Retinal fundus photograph — 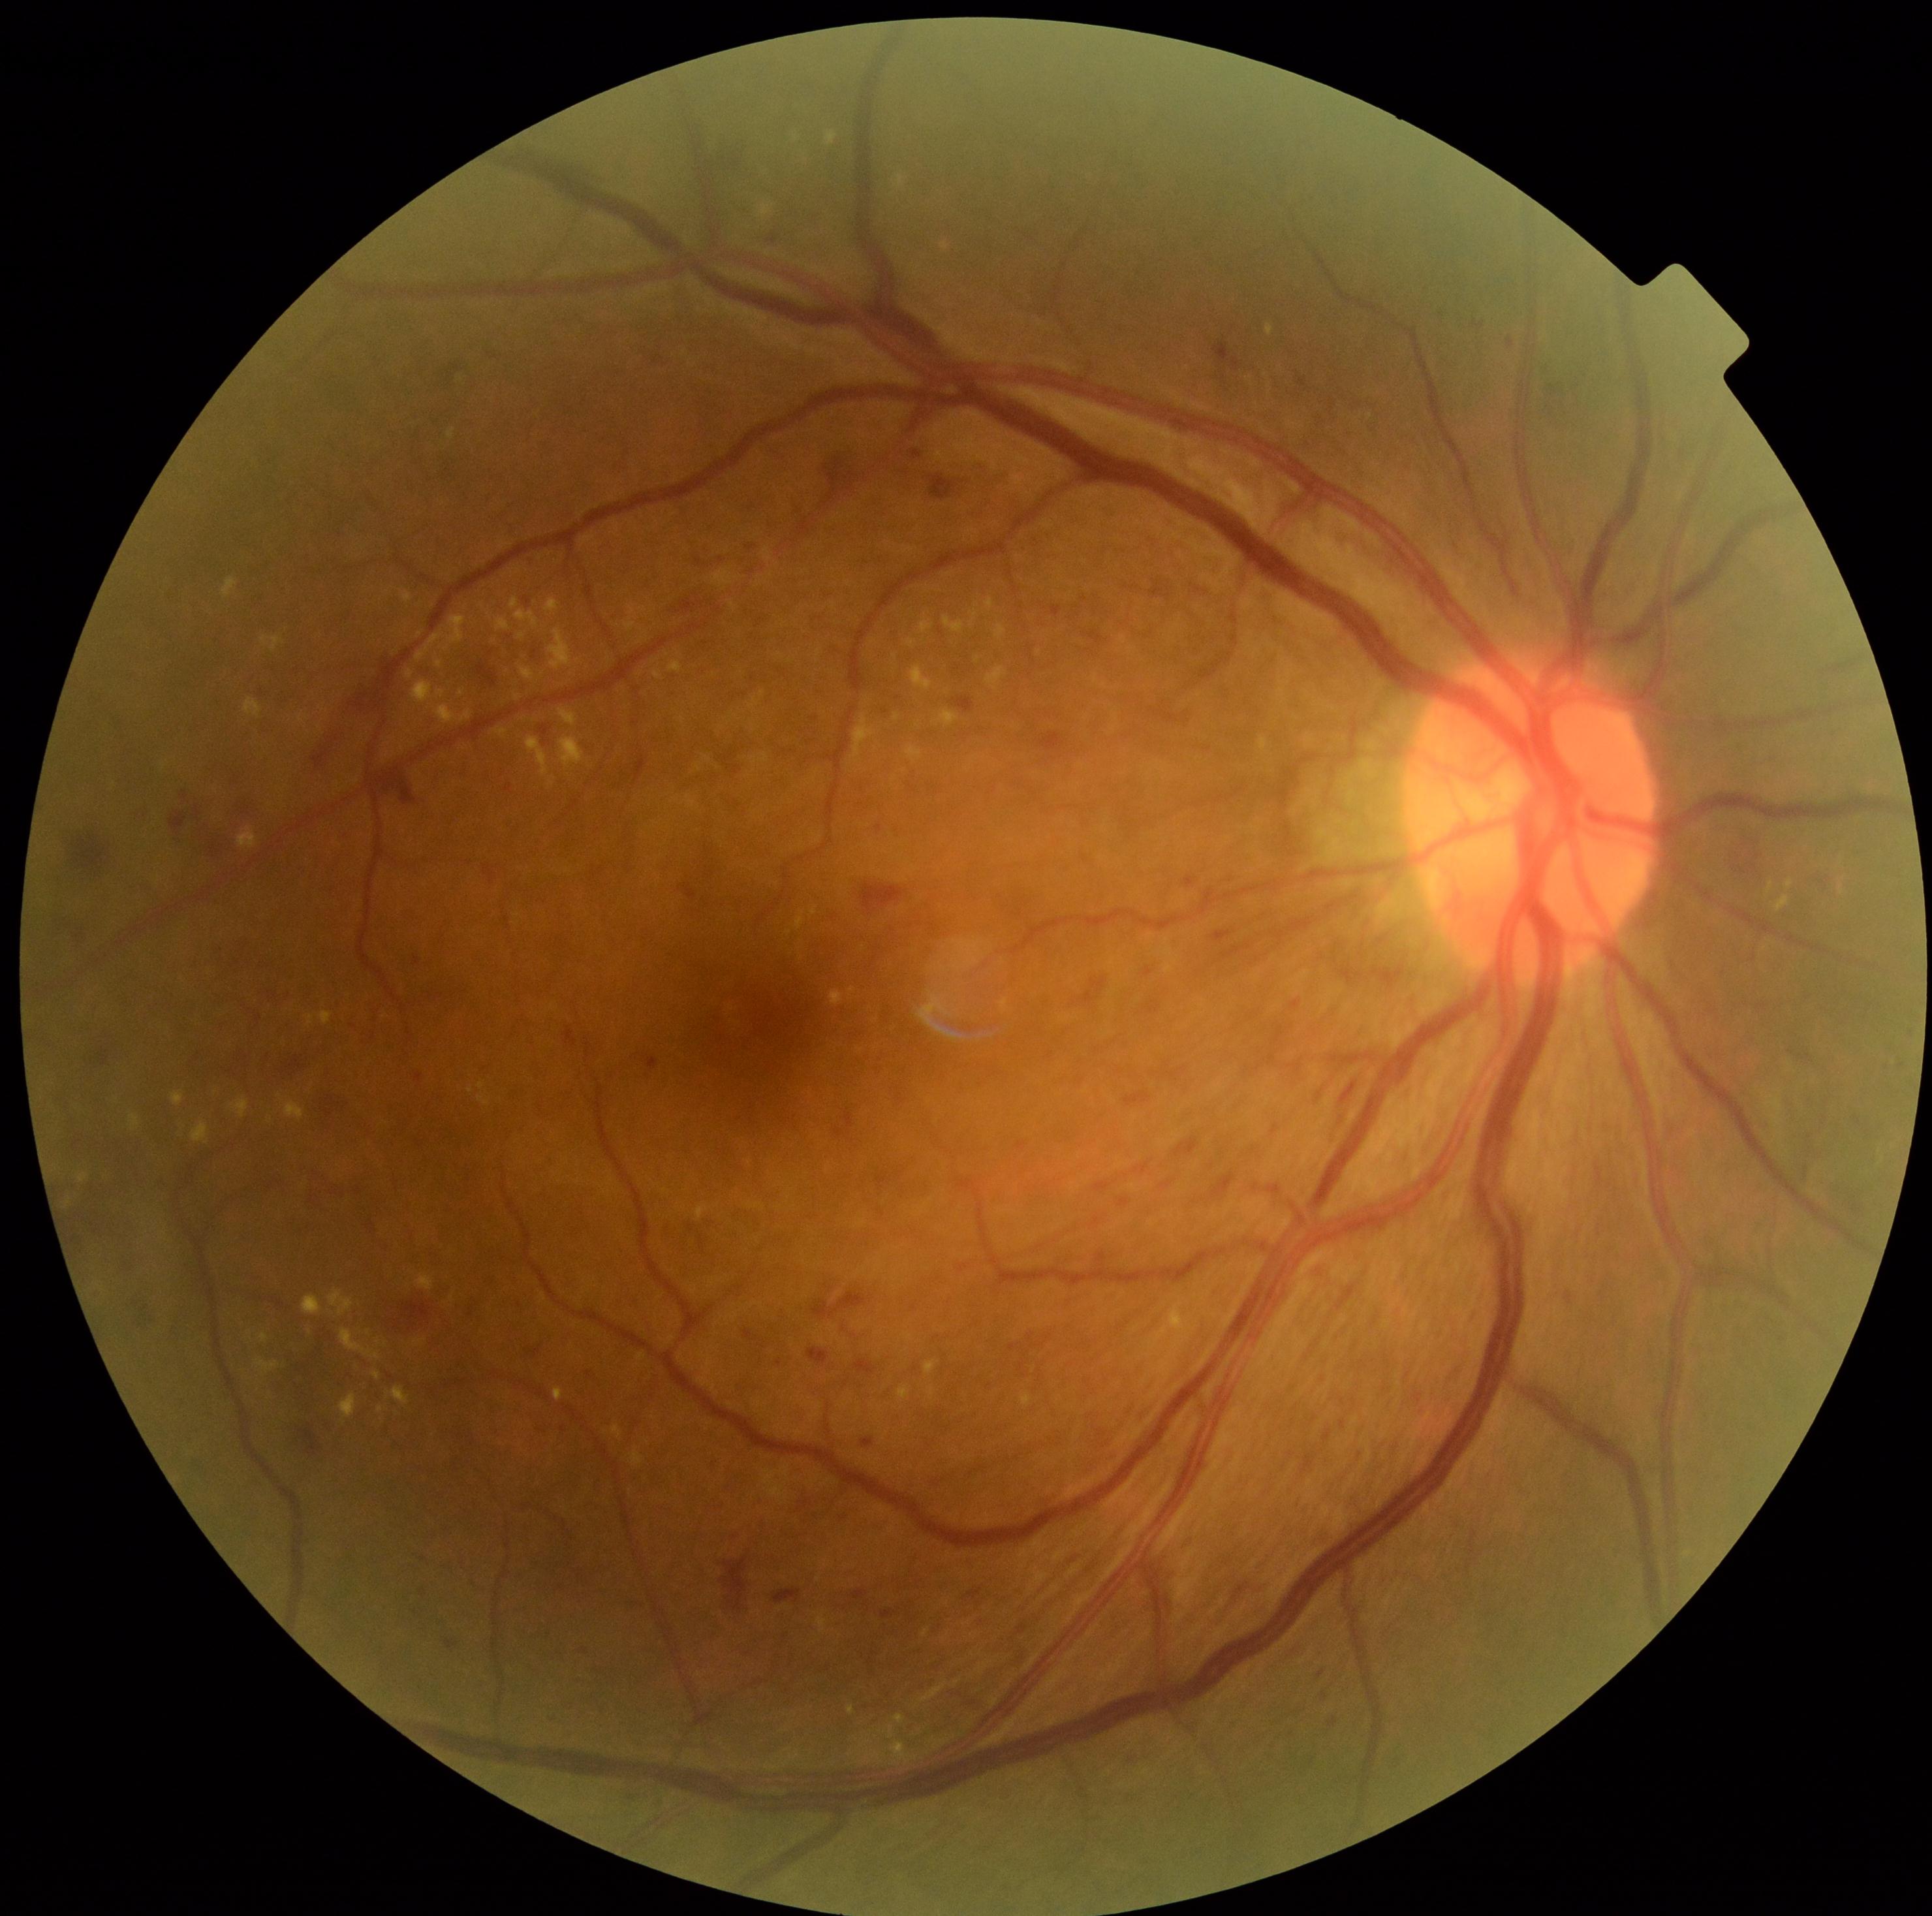
diabetic retinopathy (DR): grade 3 (severe NPDR)